Color fundus image.
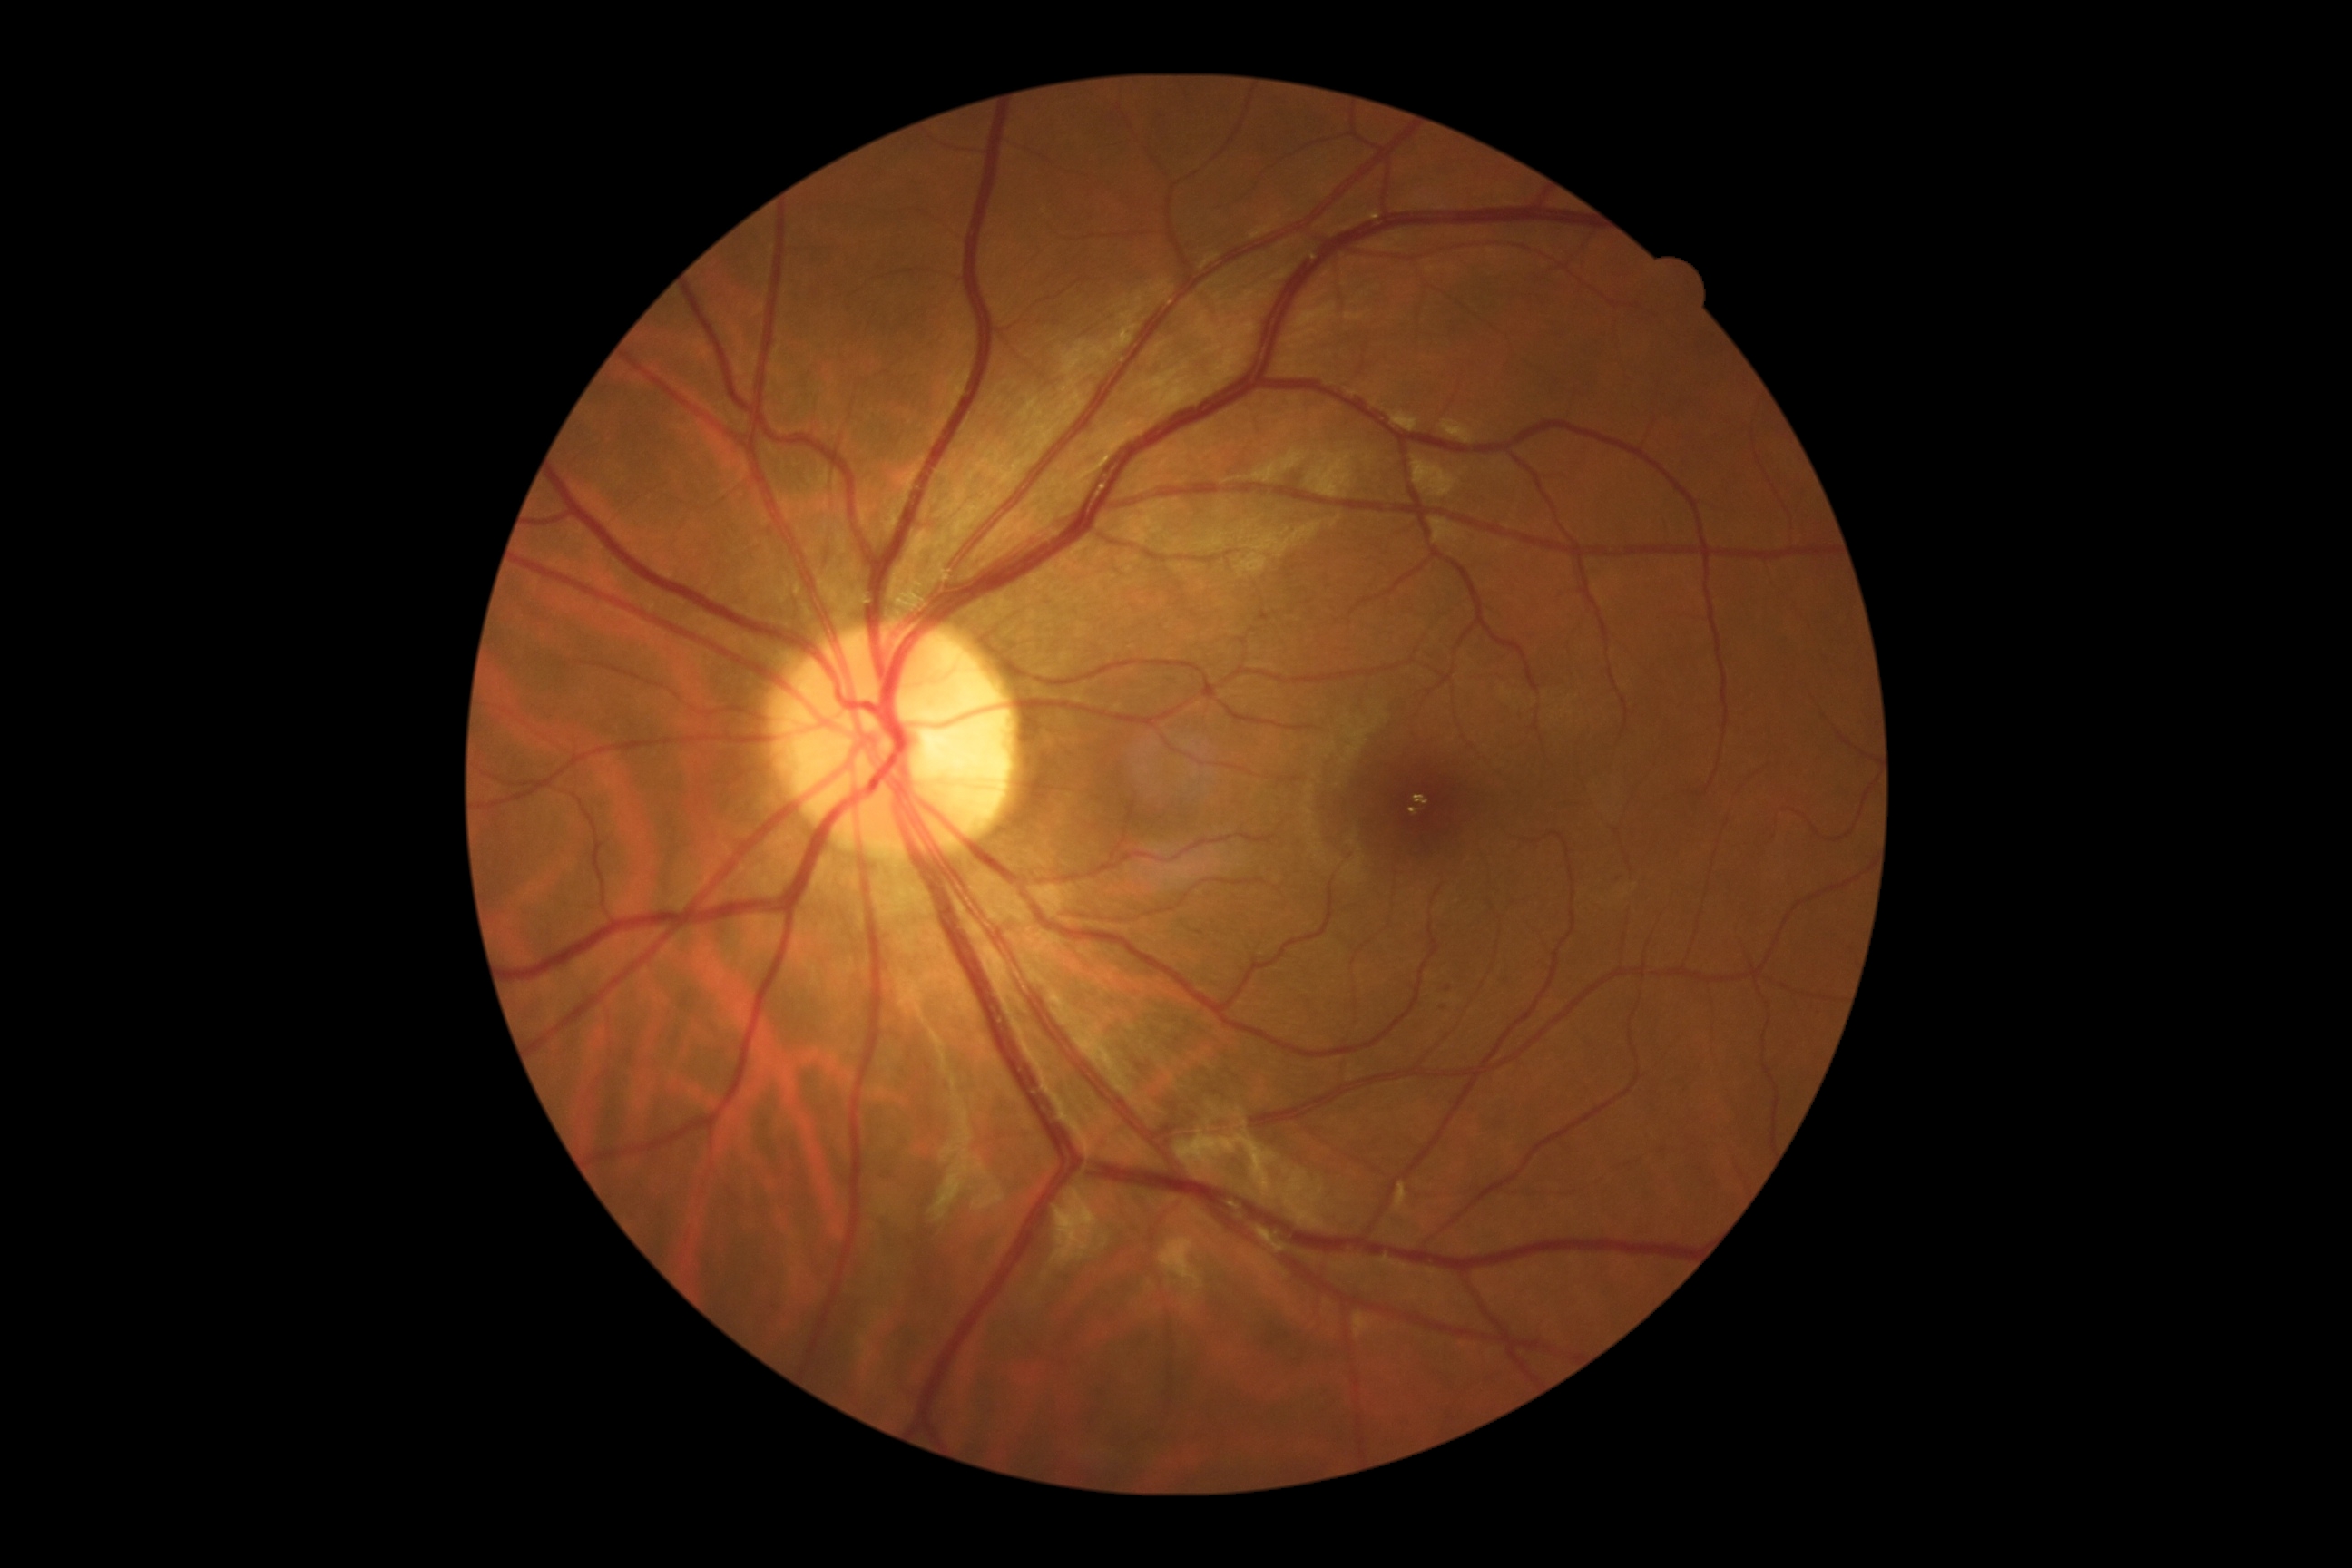

DR grade: 1/4.